Color fundus image: 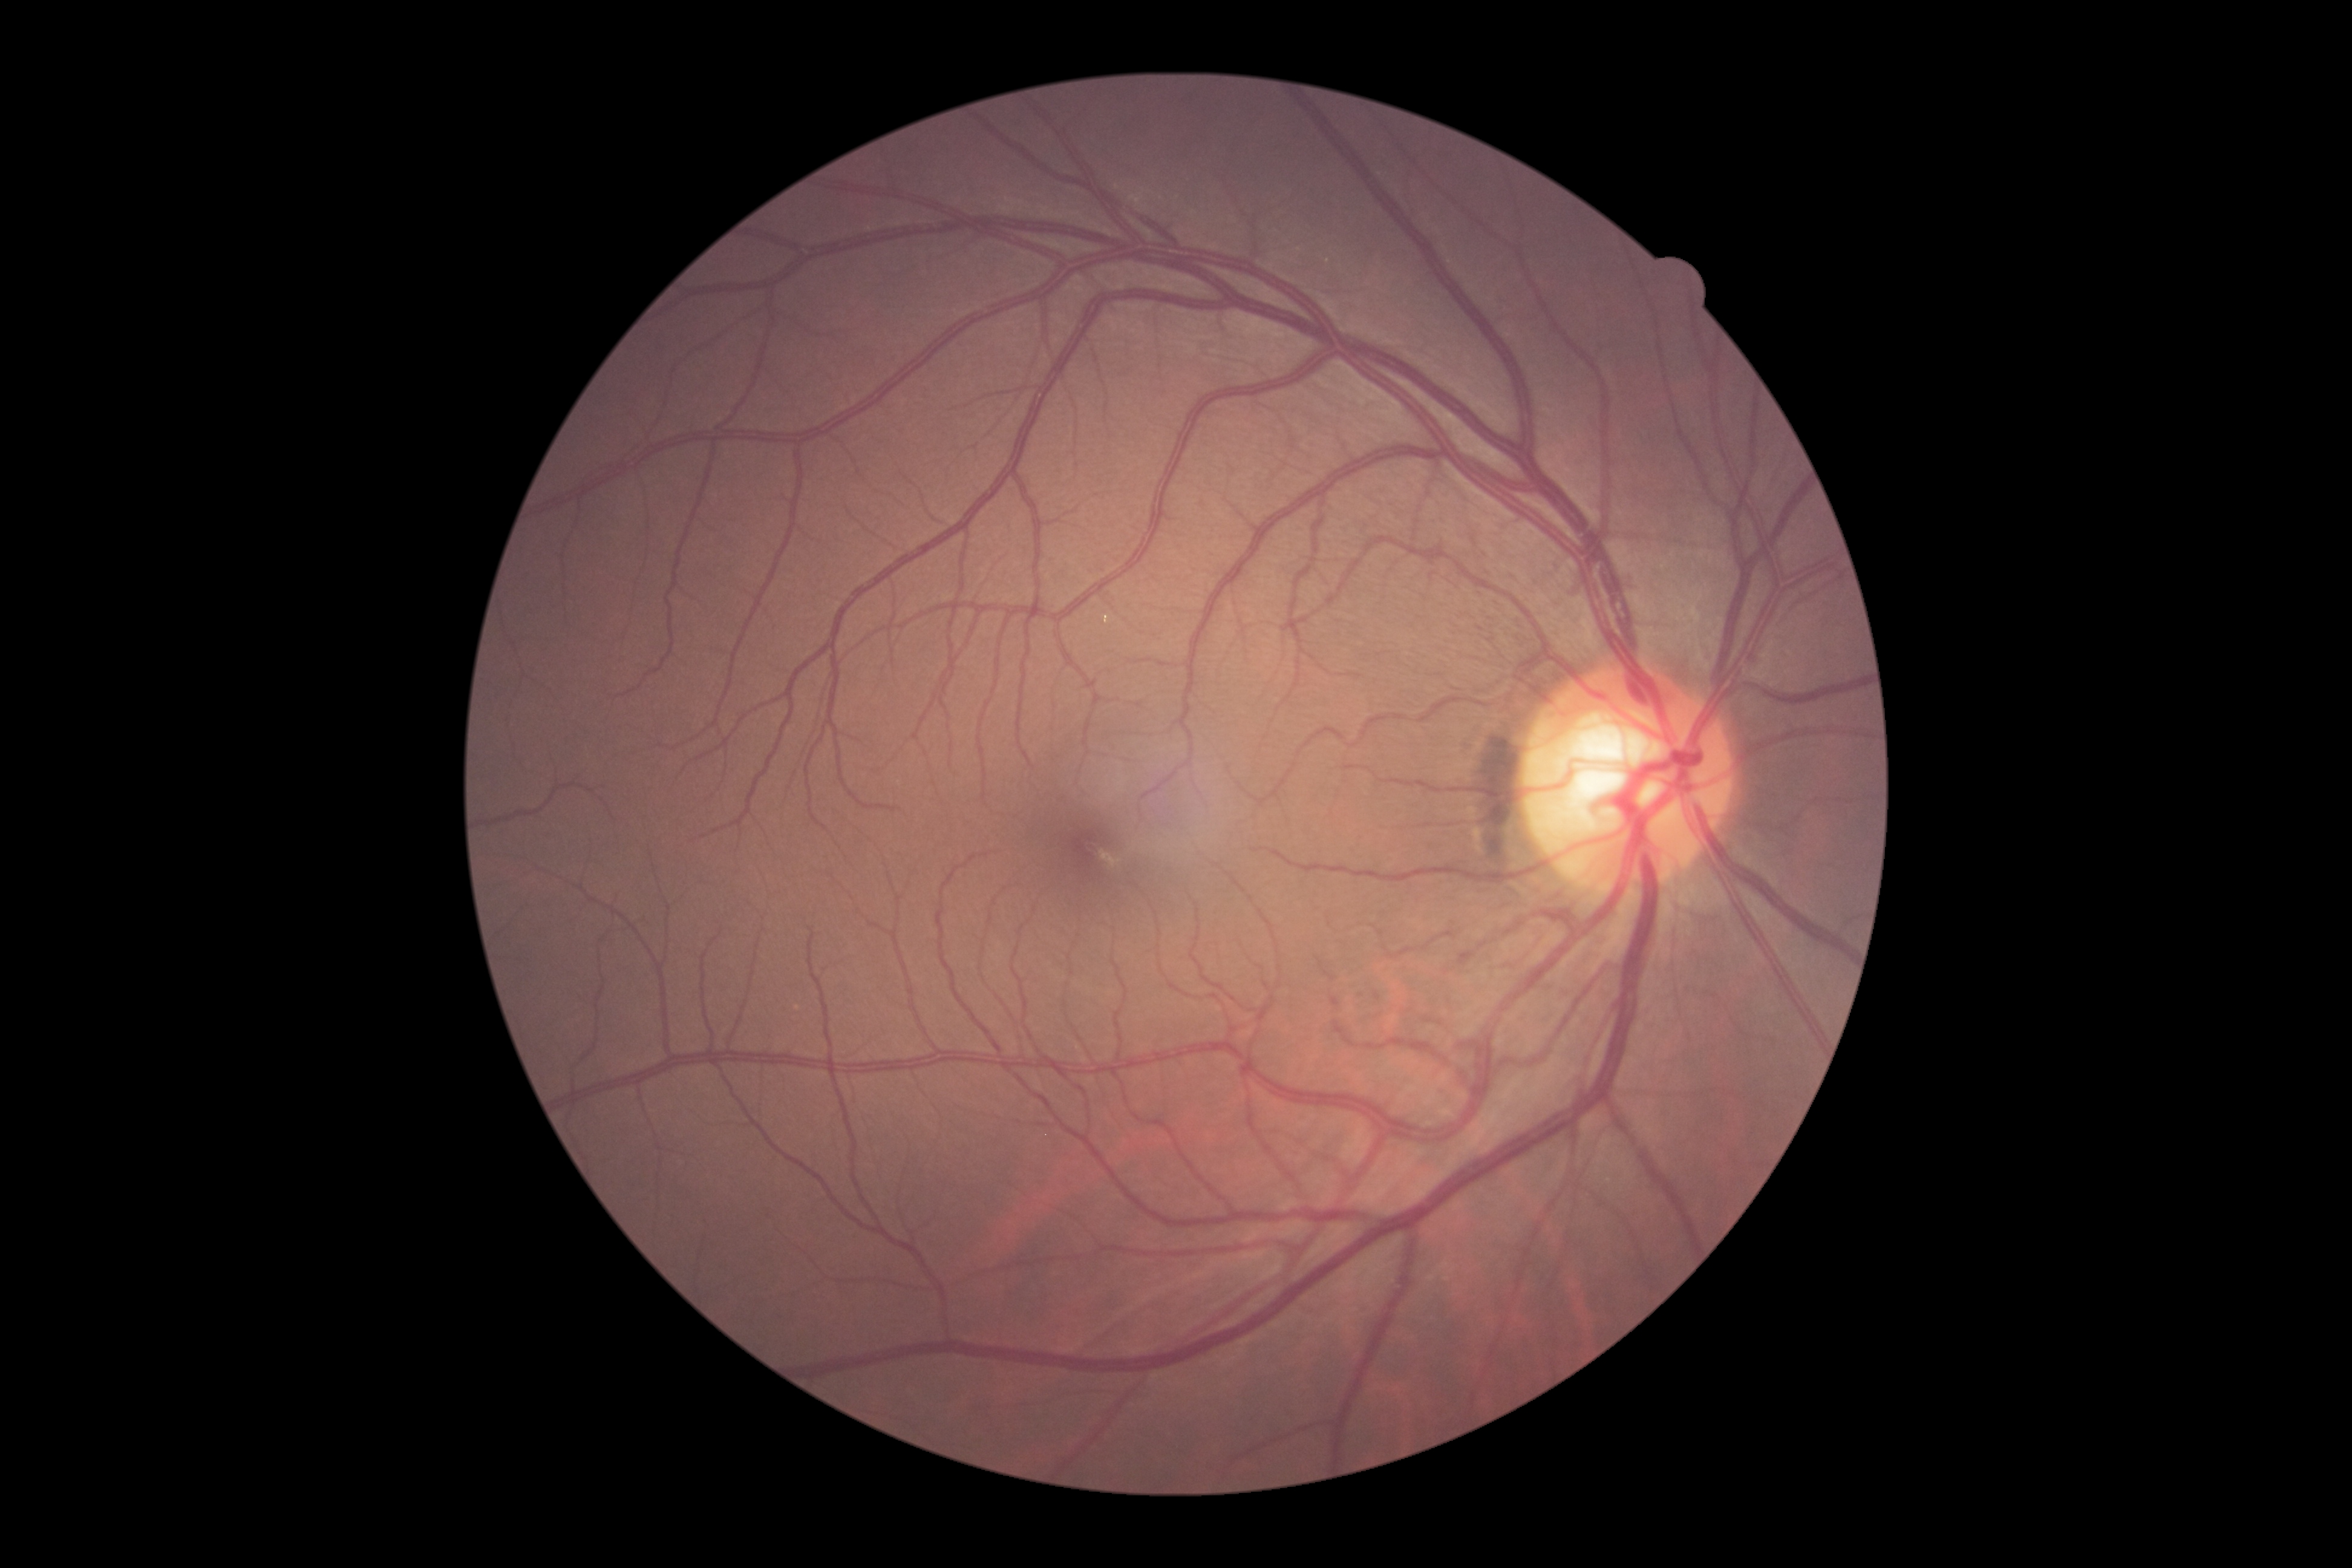
Findings:
• DR impression: no DR findings
• DR: grade 0 (no apparent retinopathy)